1924 by 1556 pixels; 200° field of view; ultra-widefield fundus photograph
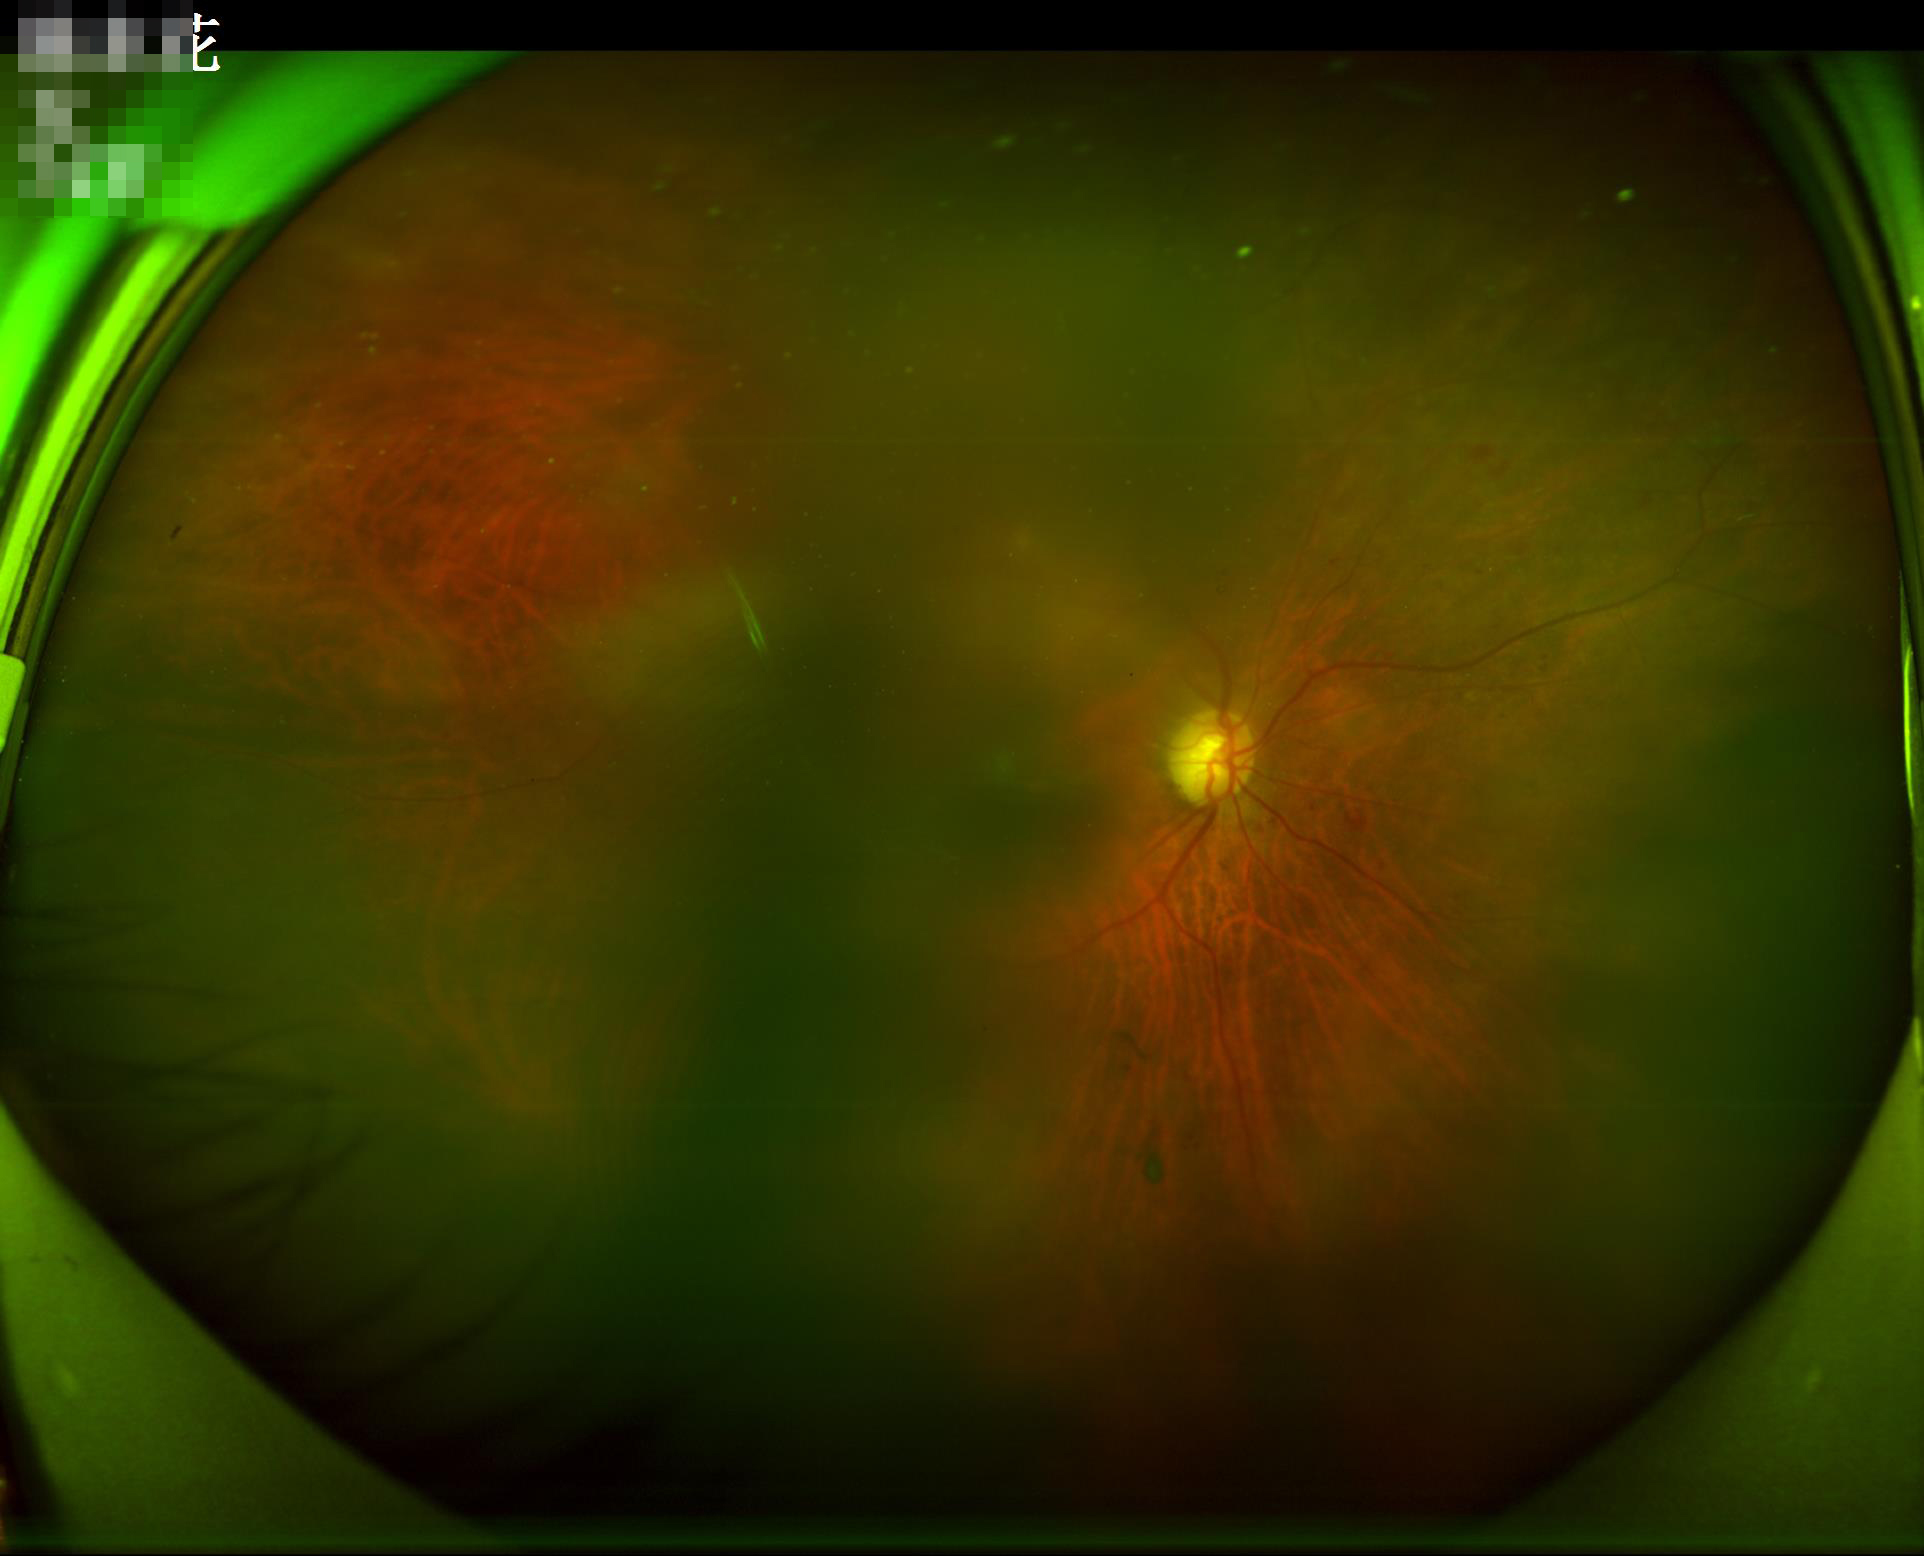
Image quality is suboptimal. Illumination and color balance are good. Reduced sharpness with visible blur.